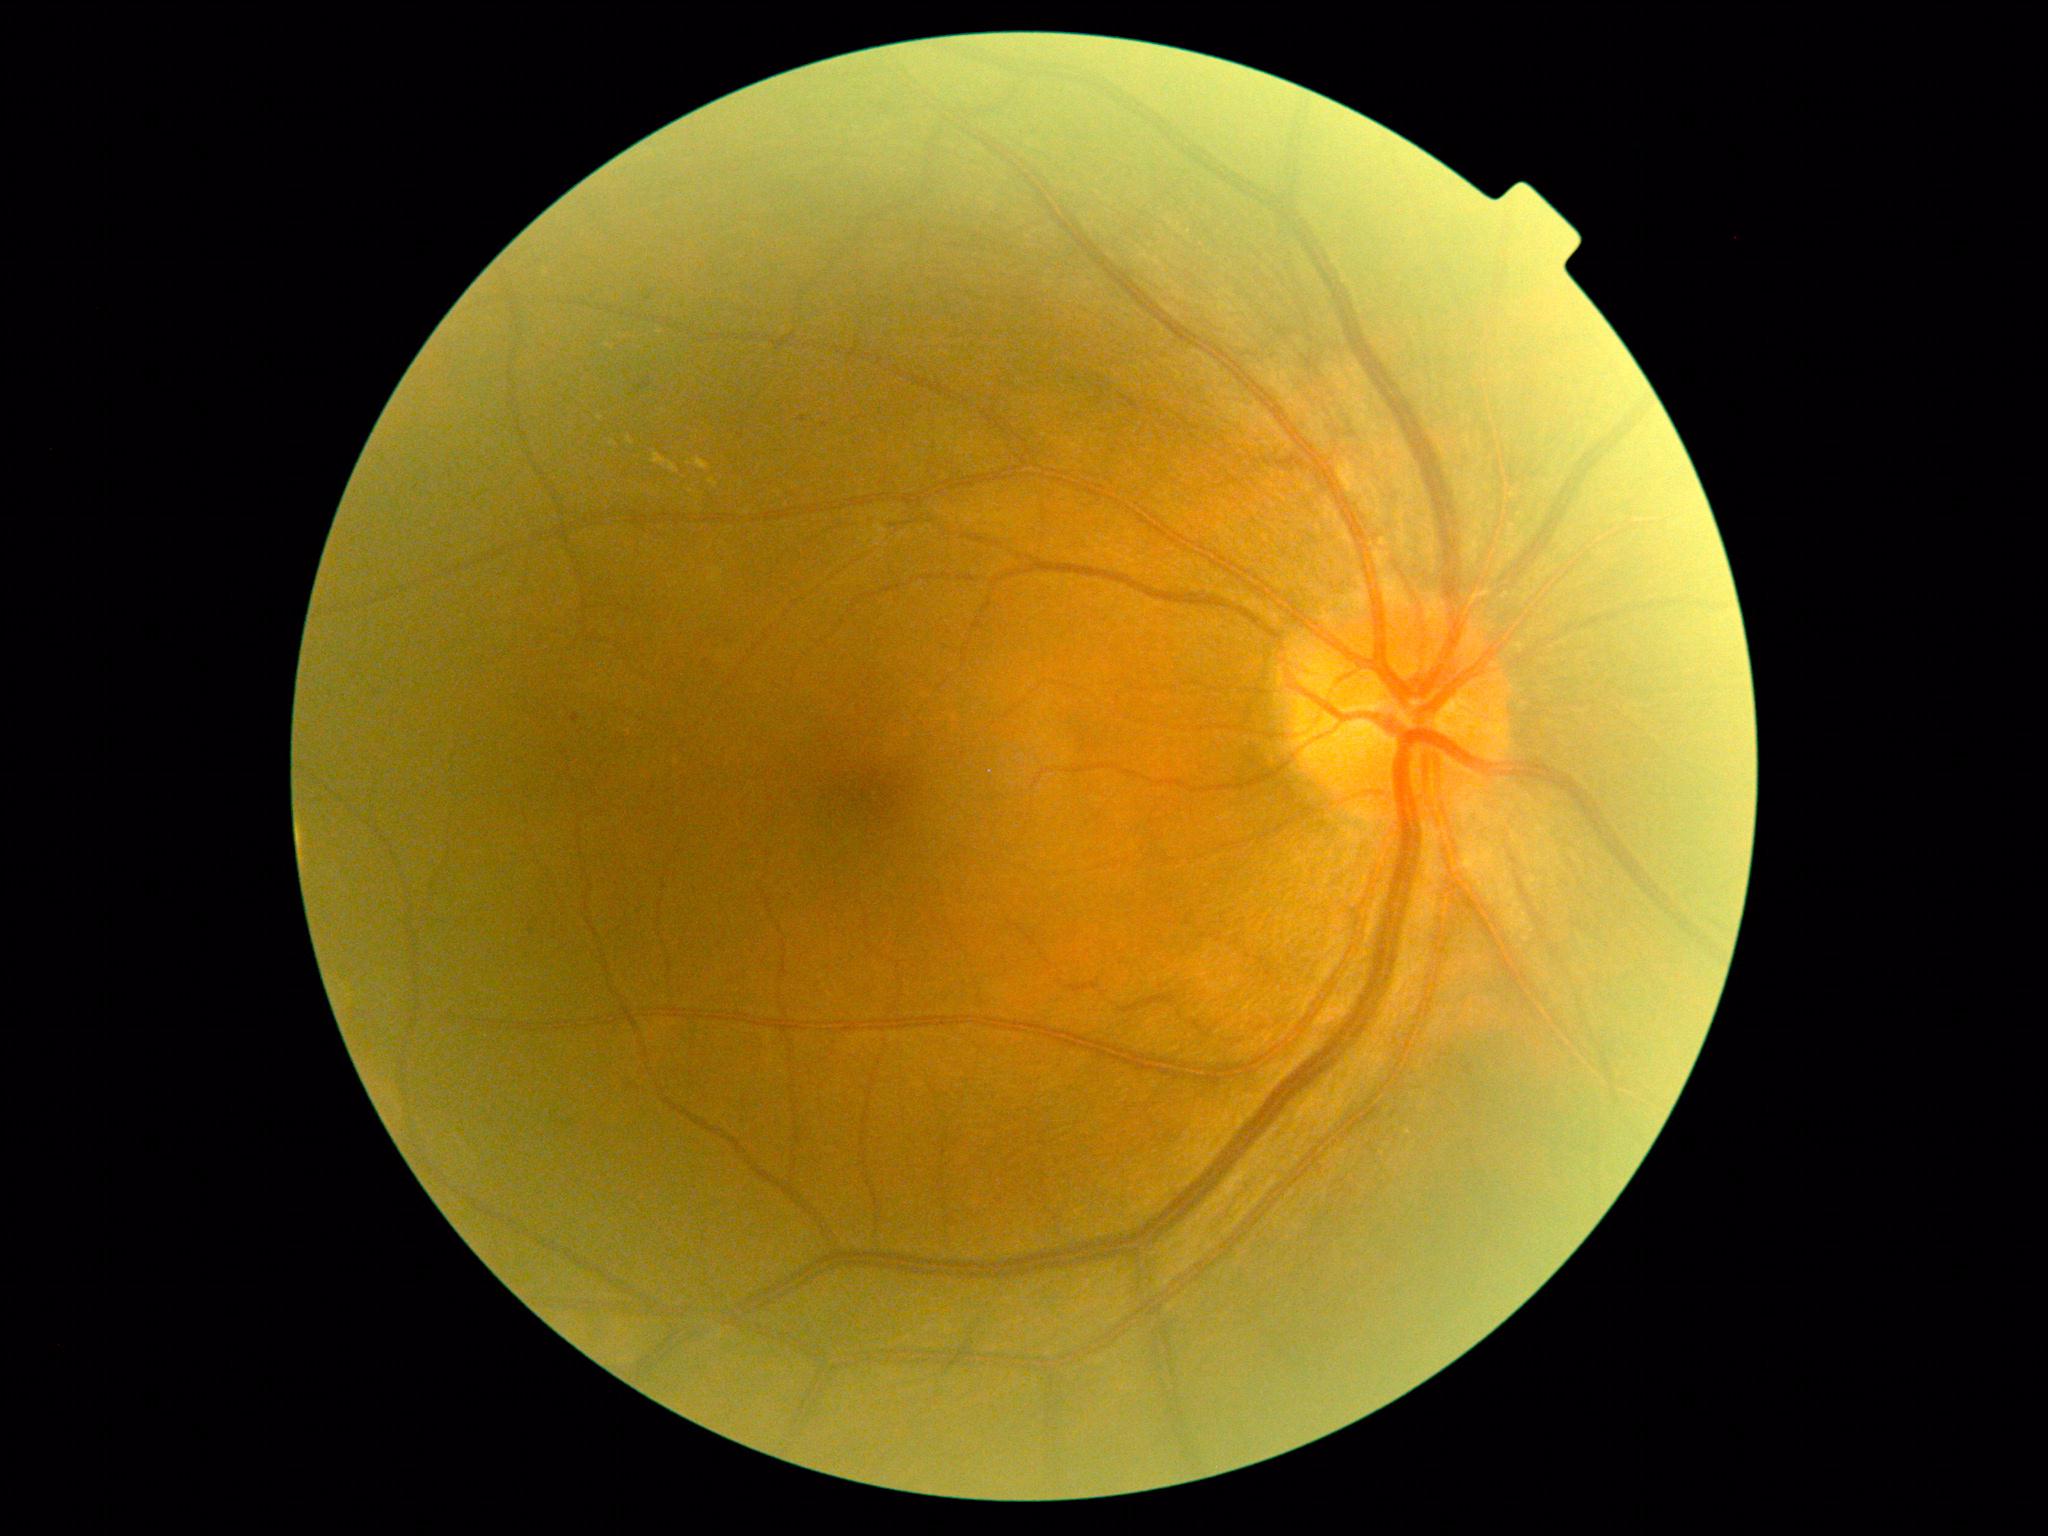
{
  "dr_category": "non-proliferative diabetic retinopathy",
  "dr_grade": "moderate non-proliferative diabetic retinopathy (grade 2)"
}